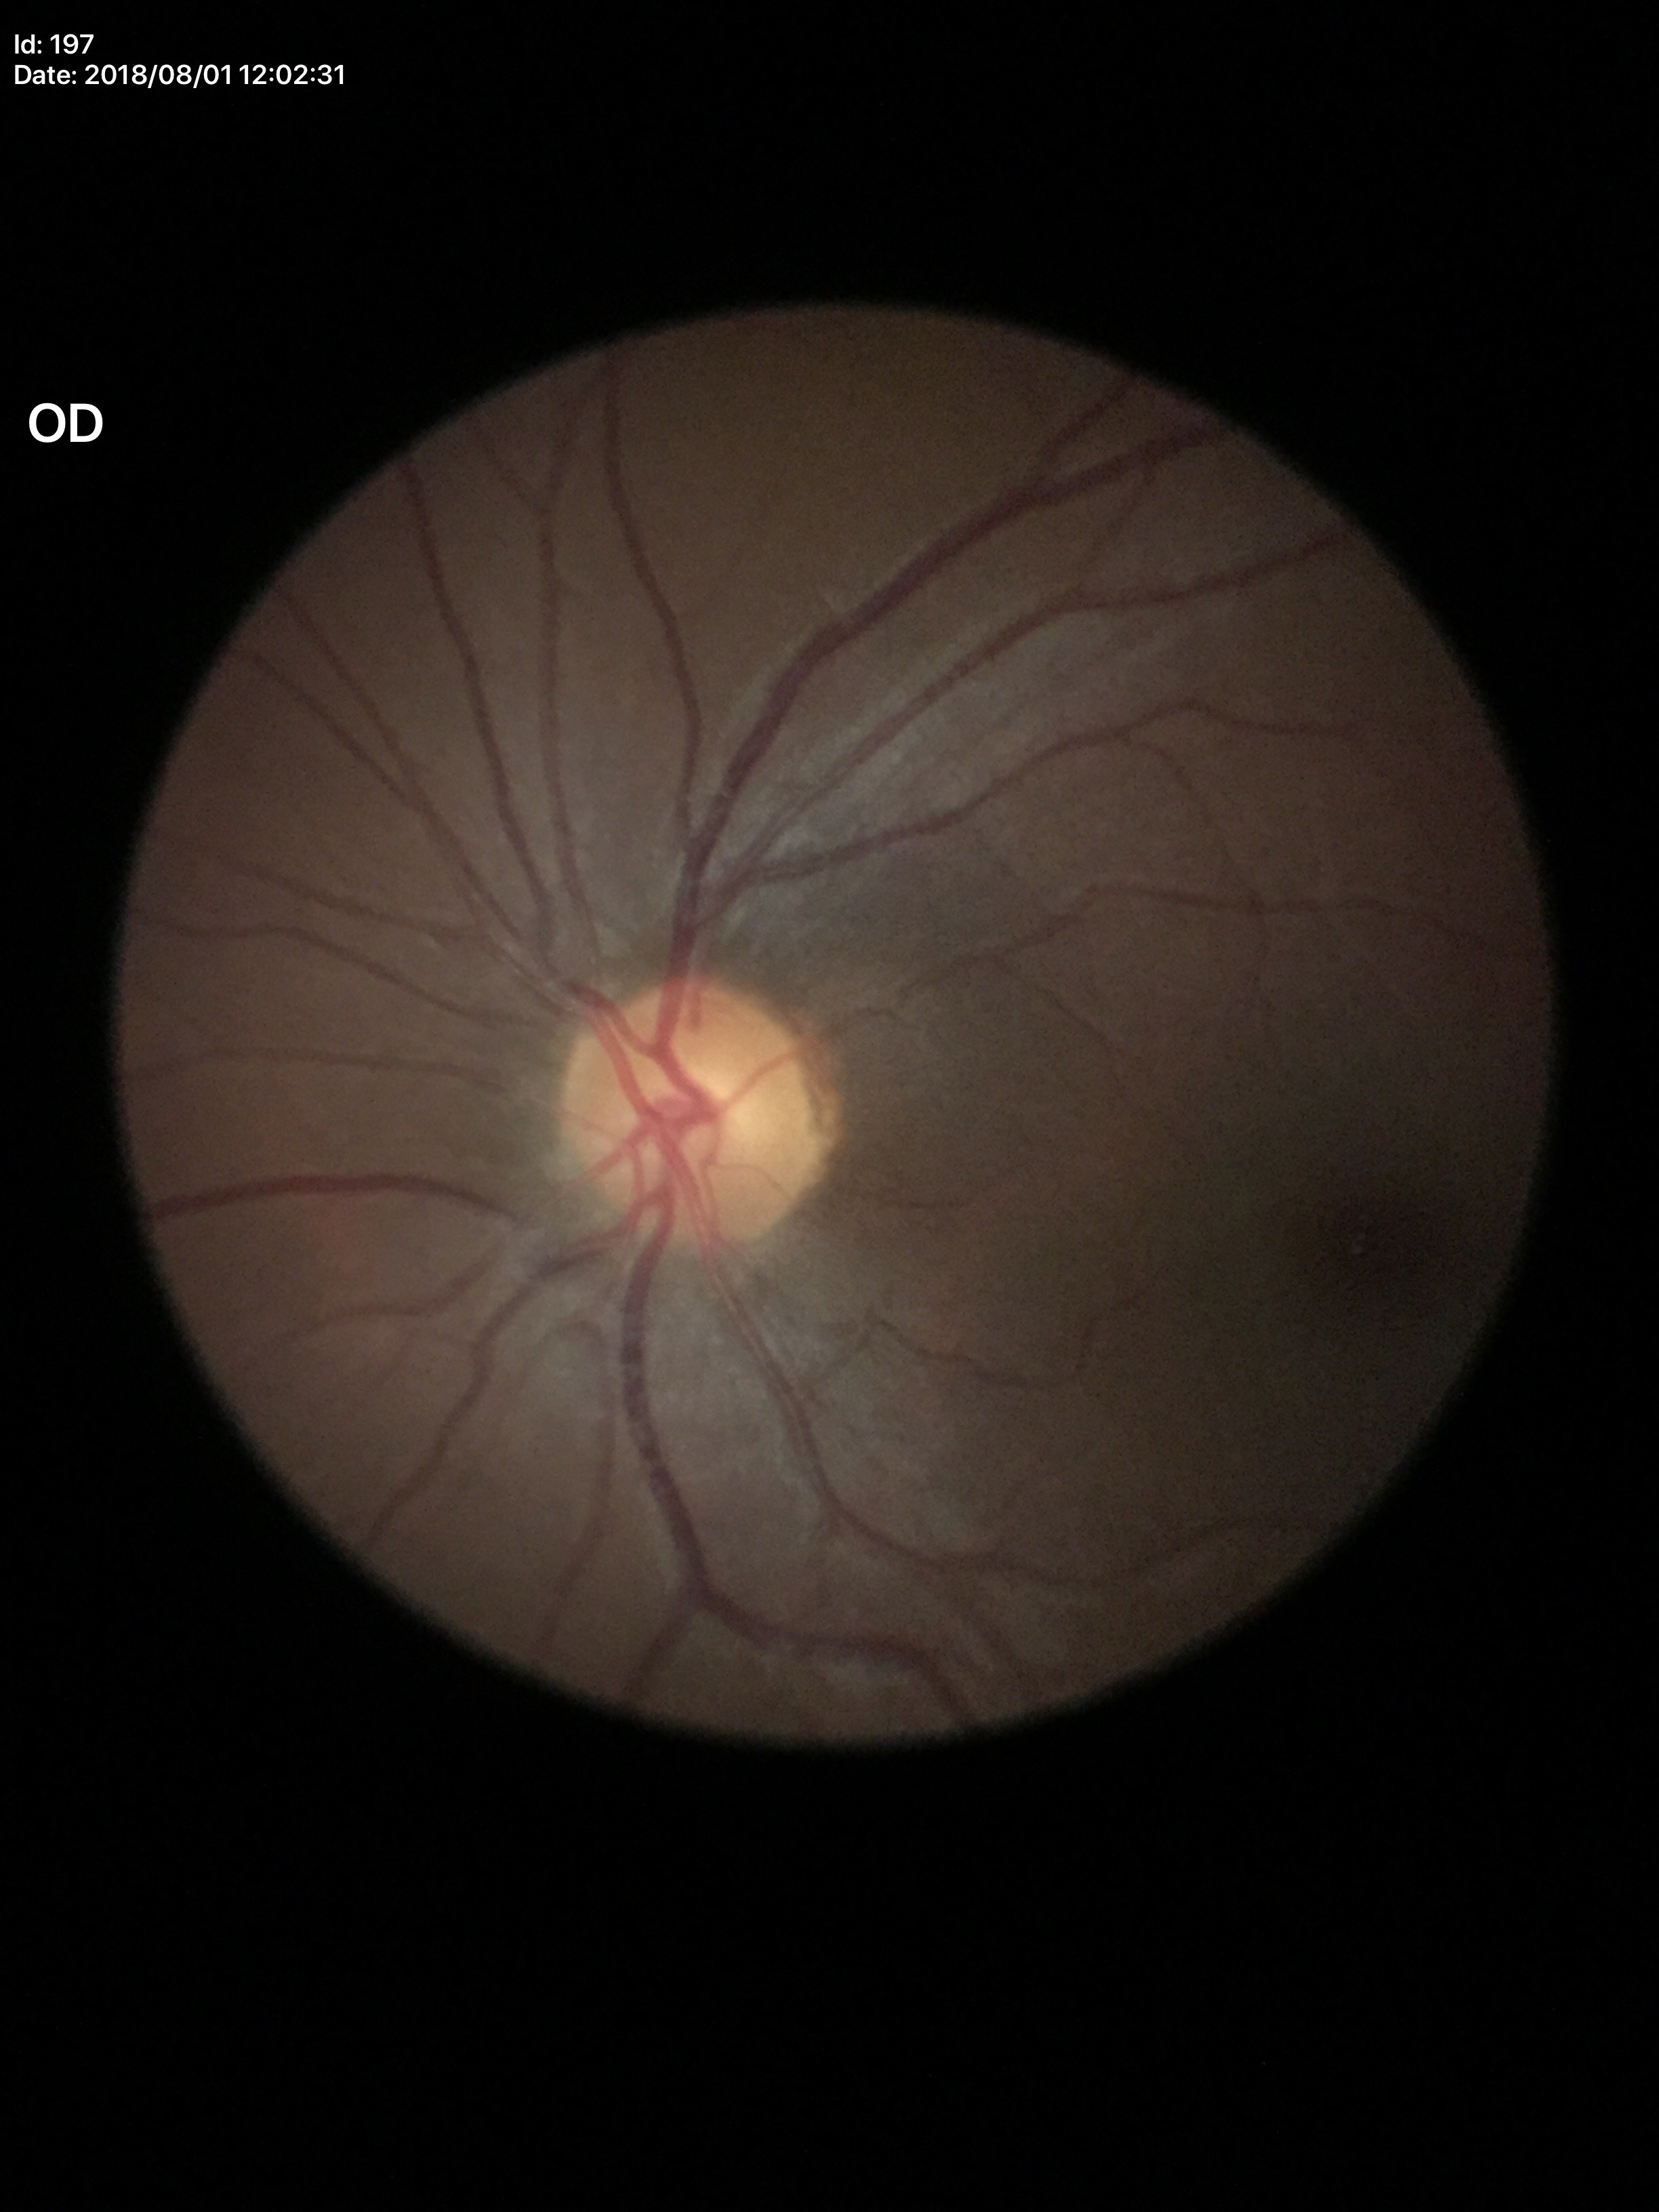
Glaucoma evaluation: negative.
Vertical cup-to-disc ratio: 0.49.
Area CDR: 0.26.